Phoenix ICON wide-field infant fundus image
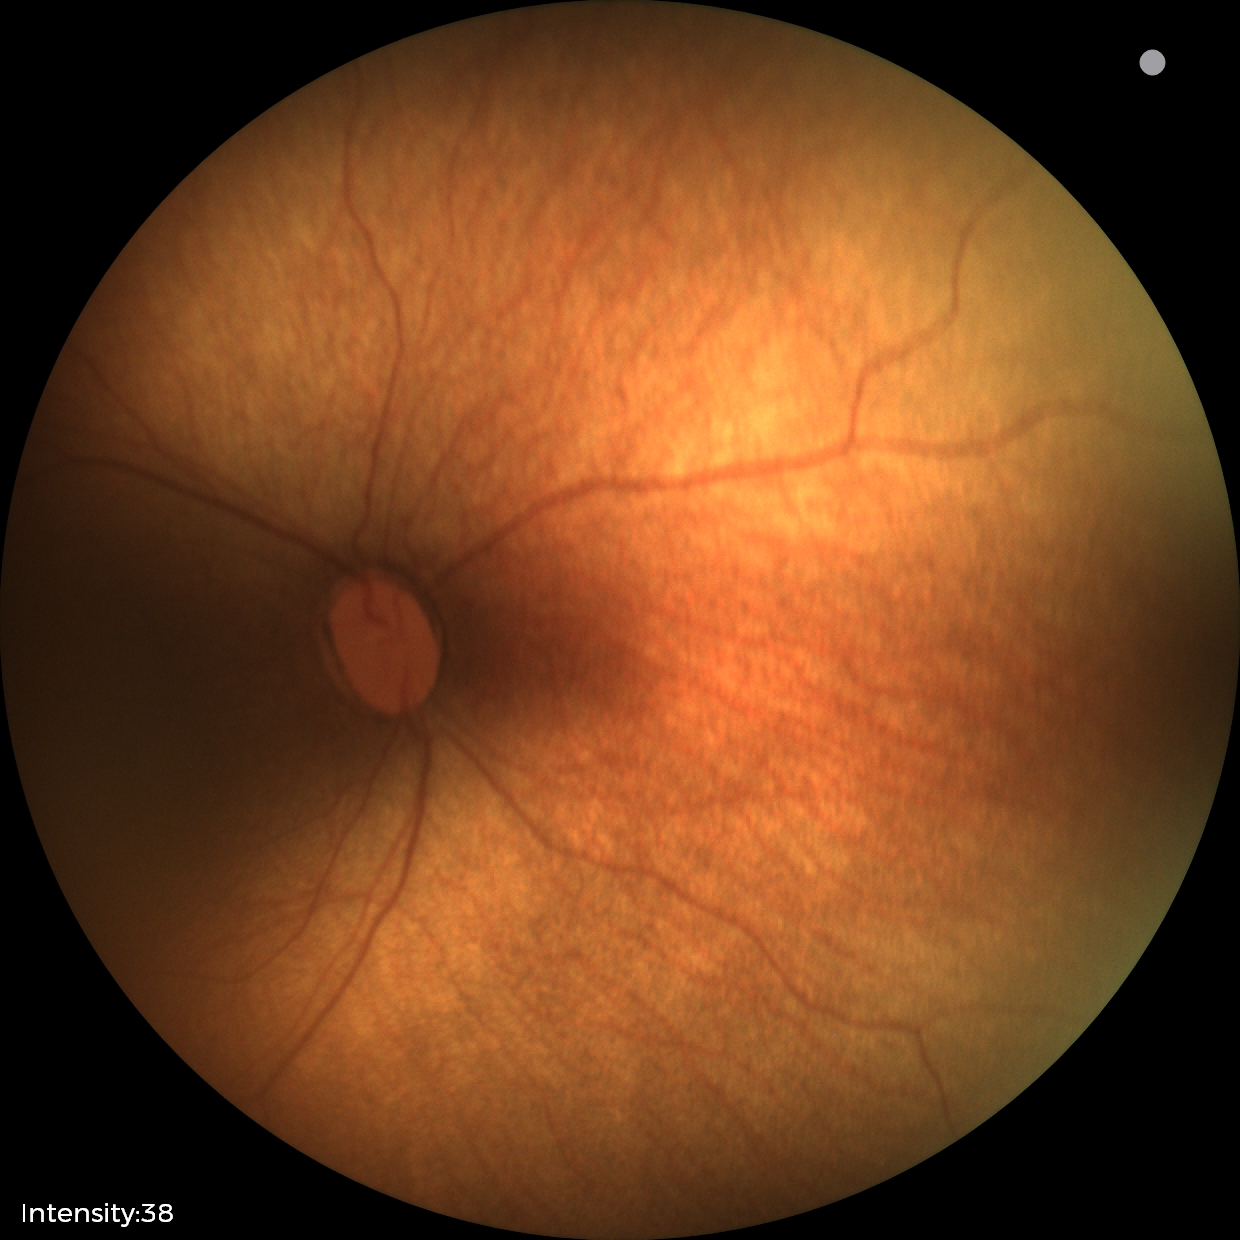 Screening examination consistent with status post retinopathy of prematurity — retinal appearance after treated retinopathy of prematurity.